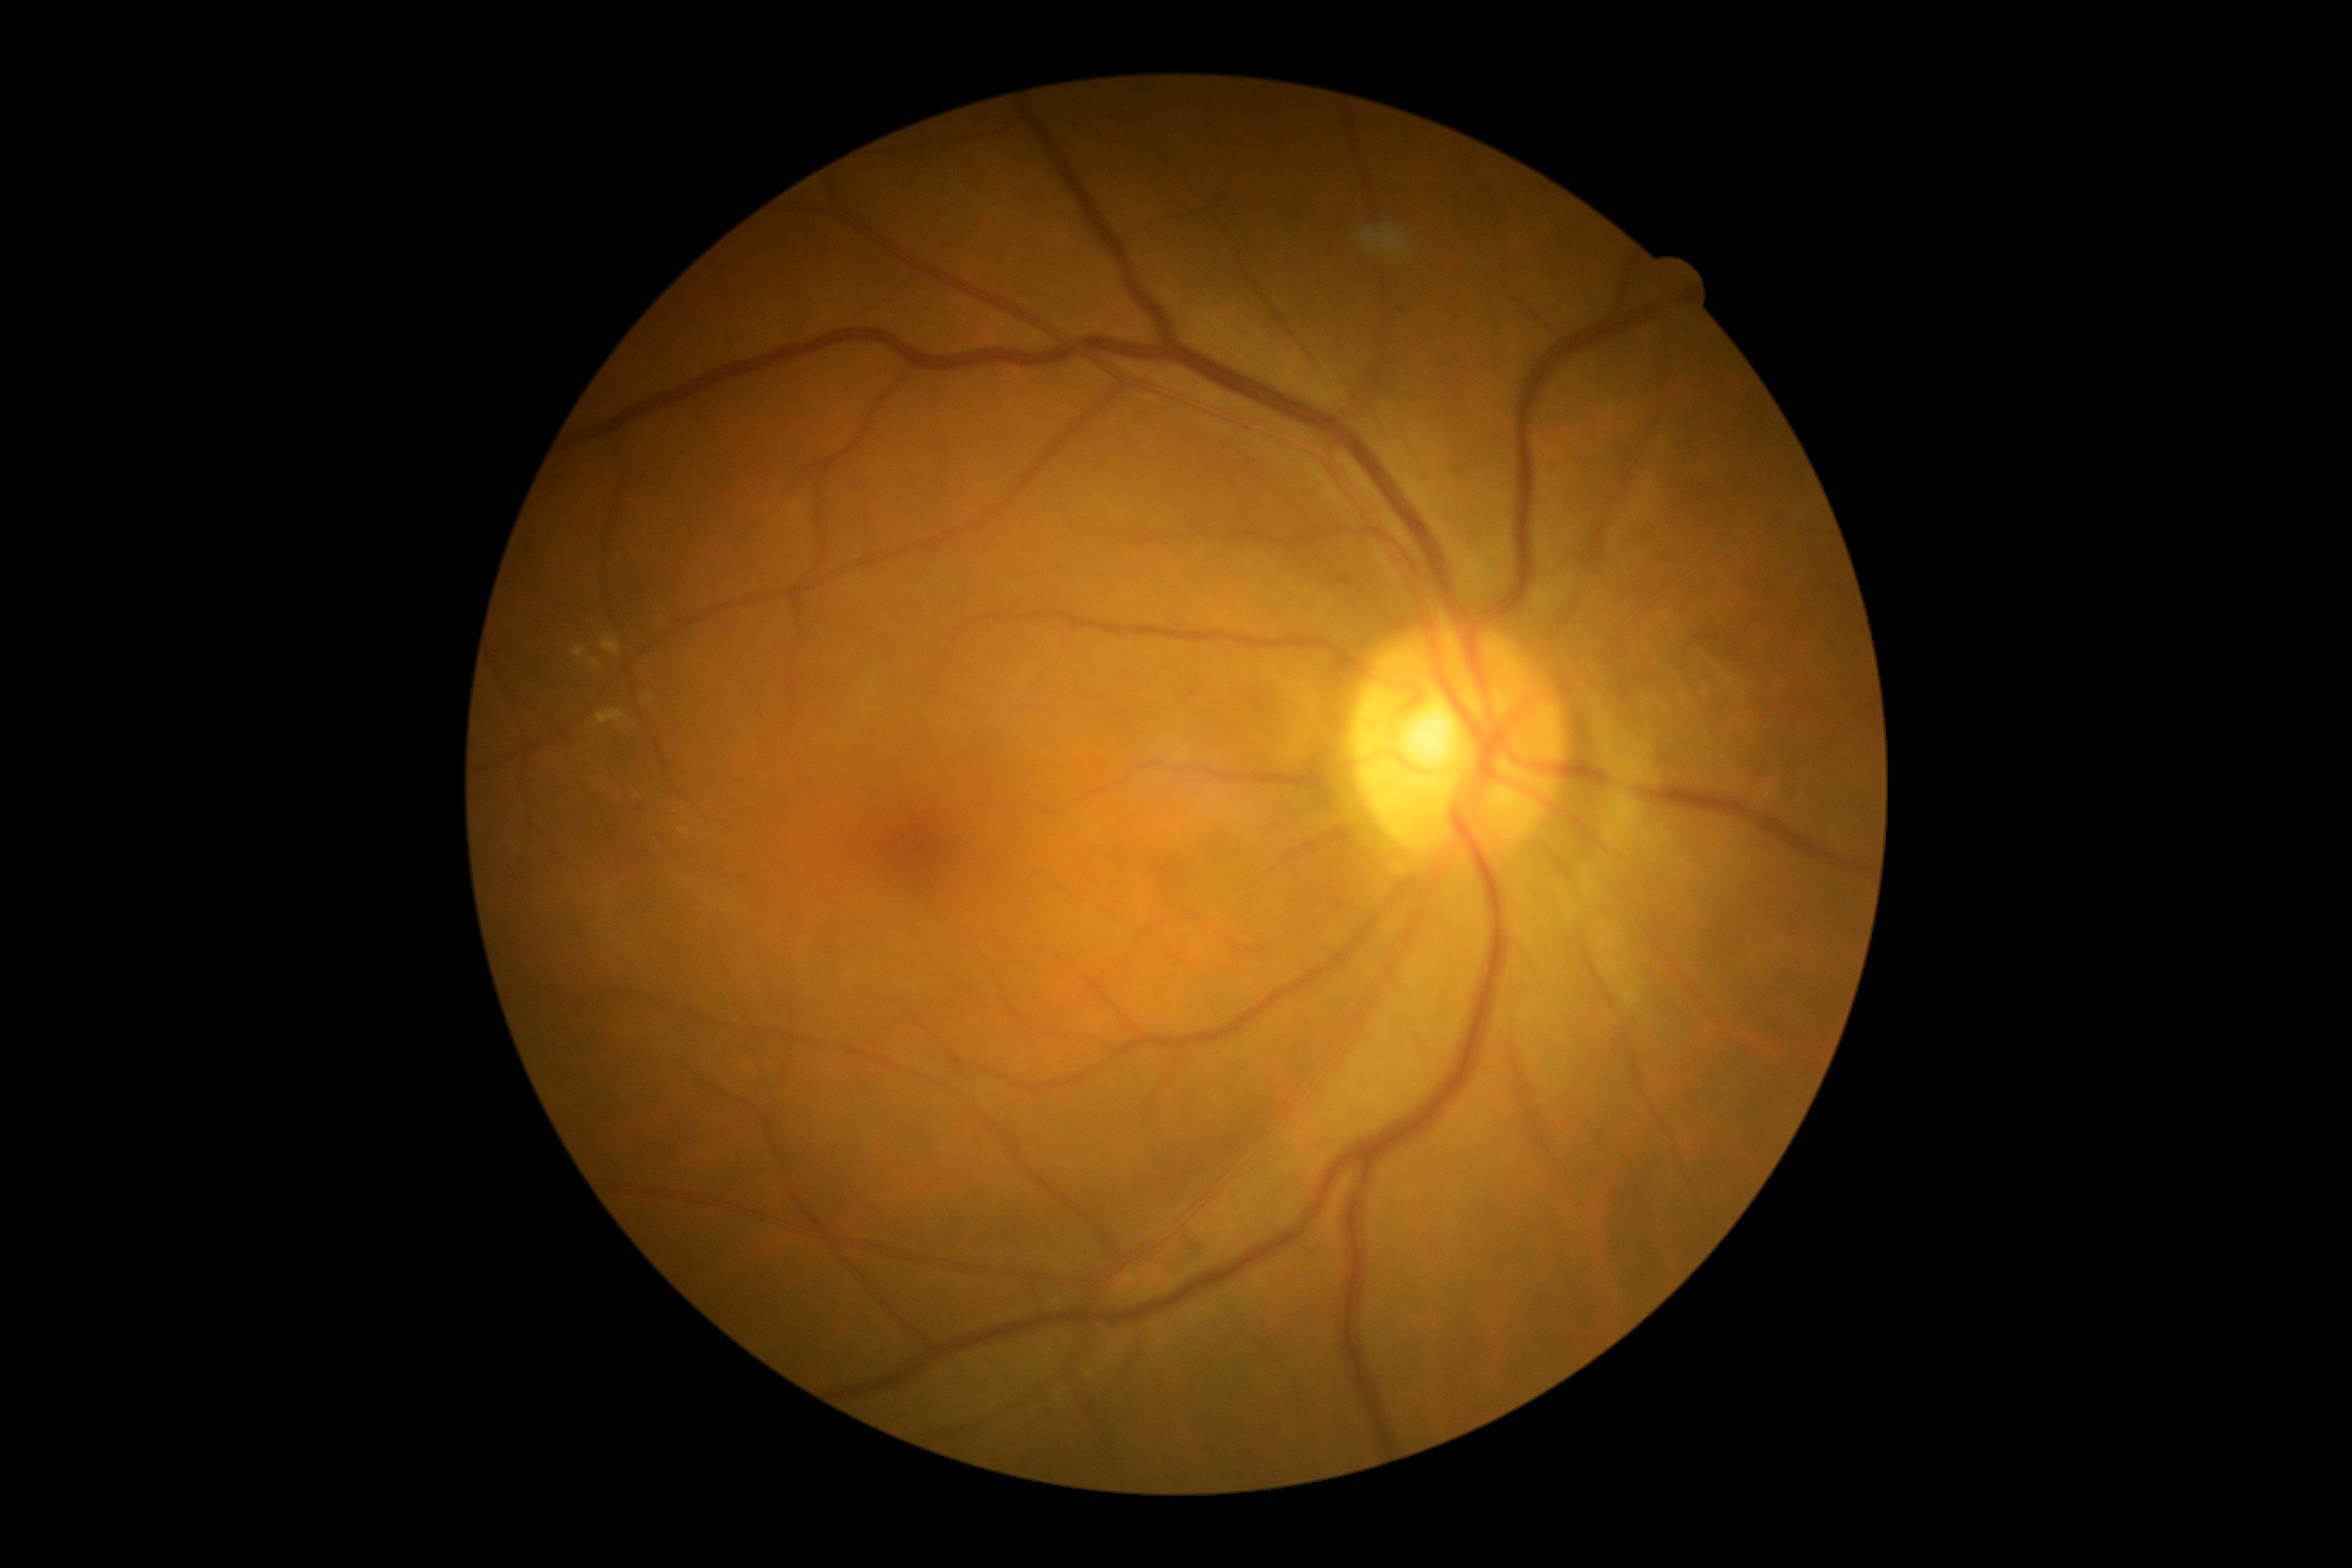 Retinopathy is grade 2 — more than just microaneurysms but less than severe NPDR.